Color fundus photograph
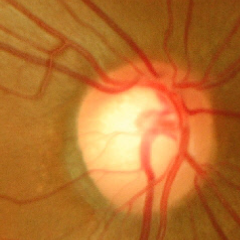 There is evidence of no glaucomatous optic neuropathy.